Diabetic retinopathy graded by the modified Davis classification: 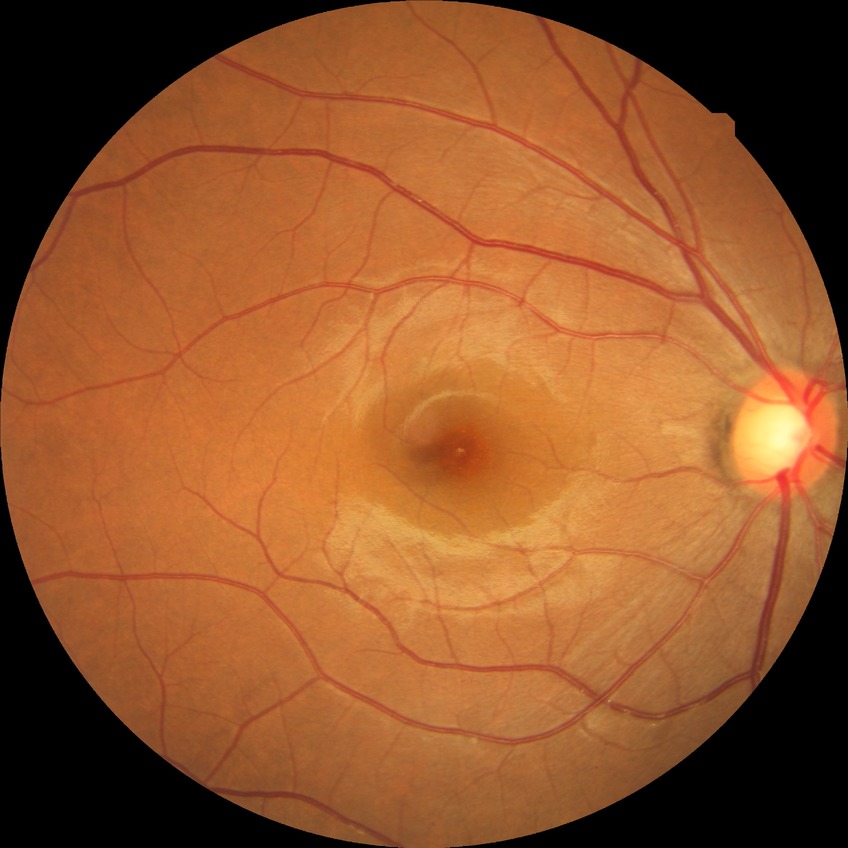
diabetic retinopathy (DR) = NDR (no diabetic retinopathy).